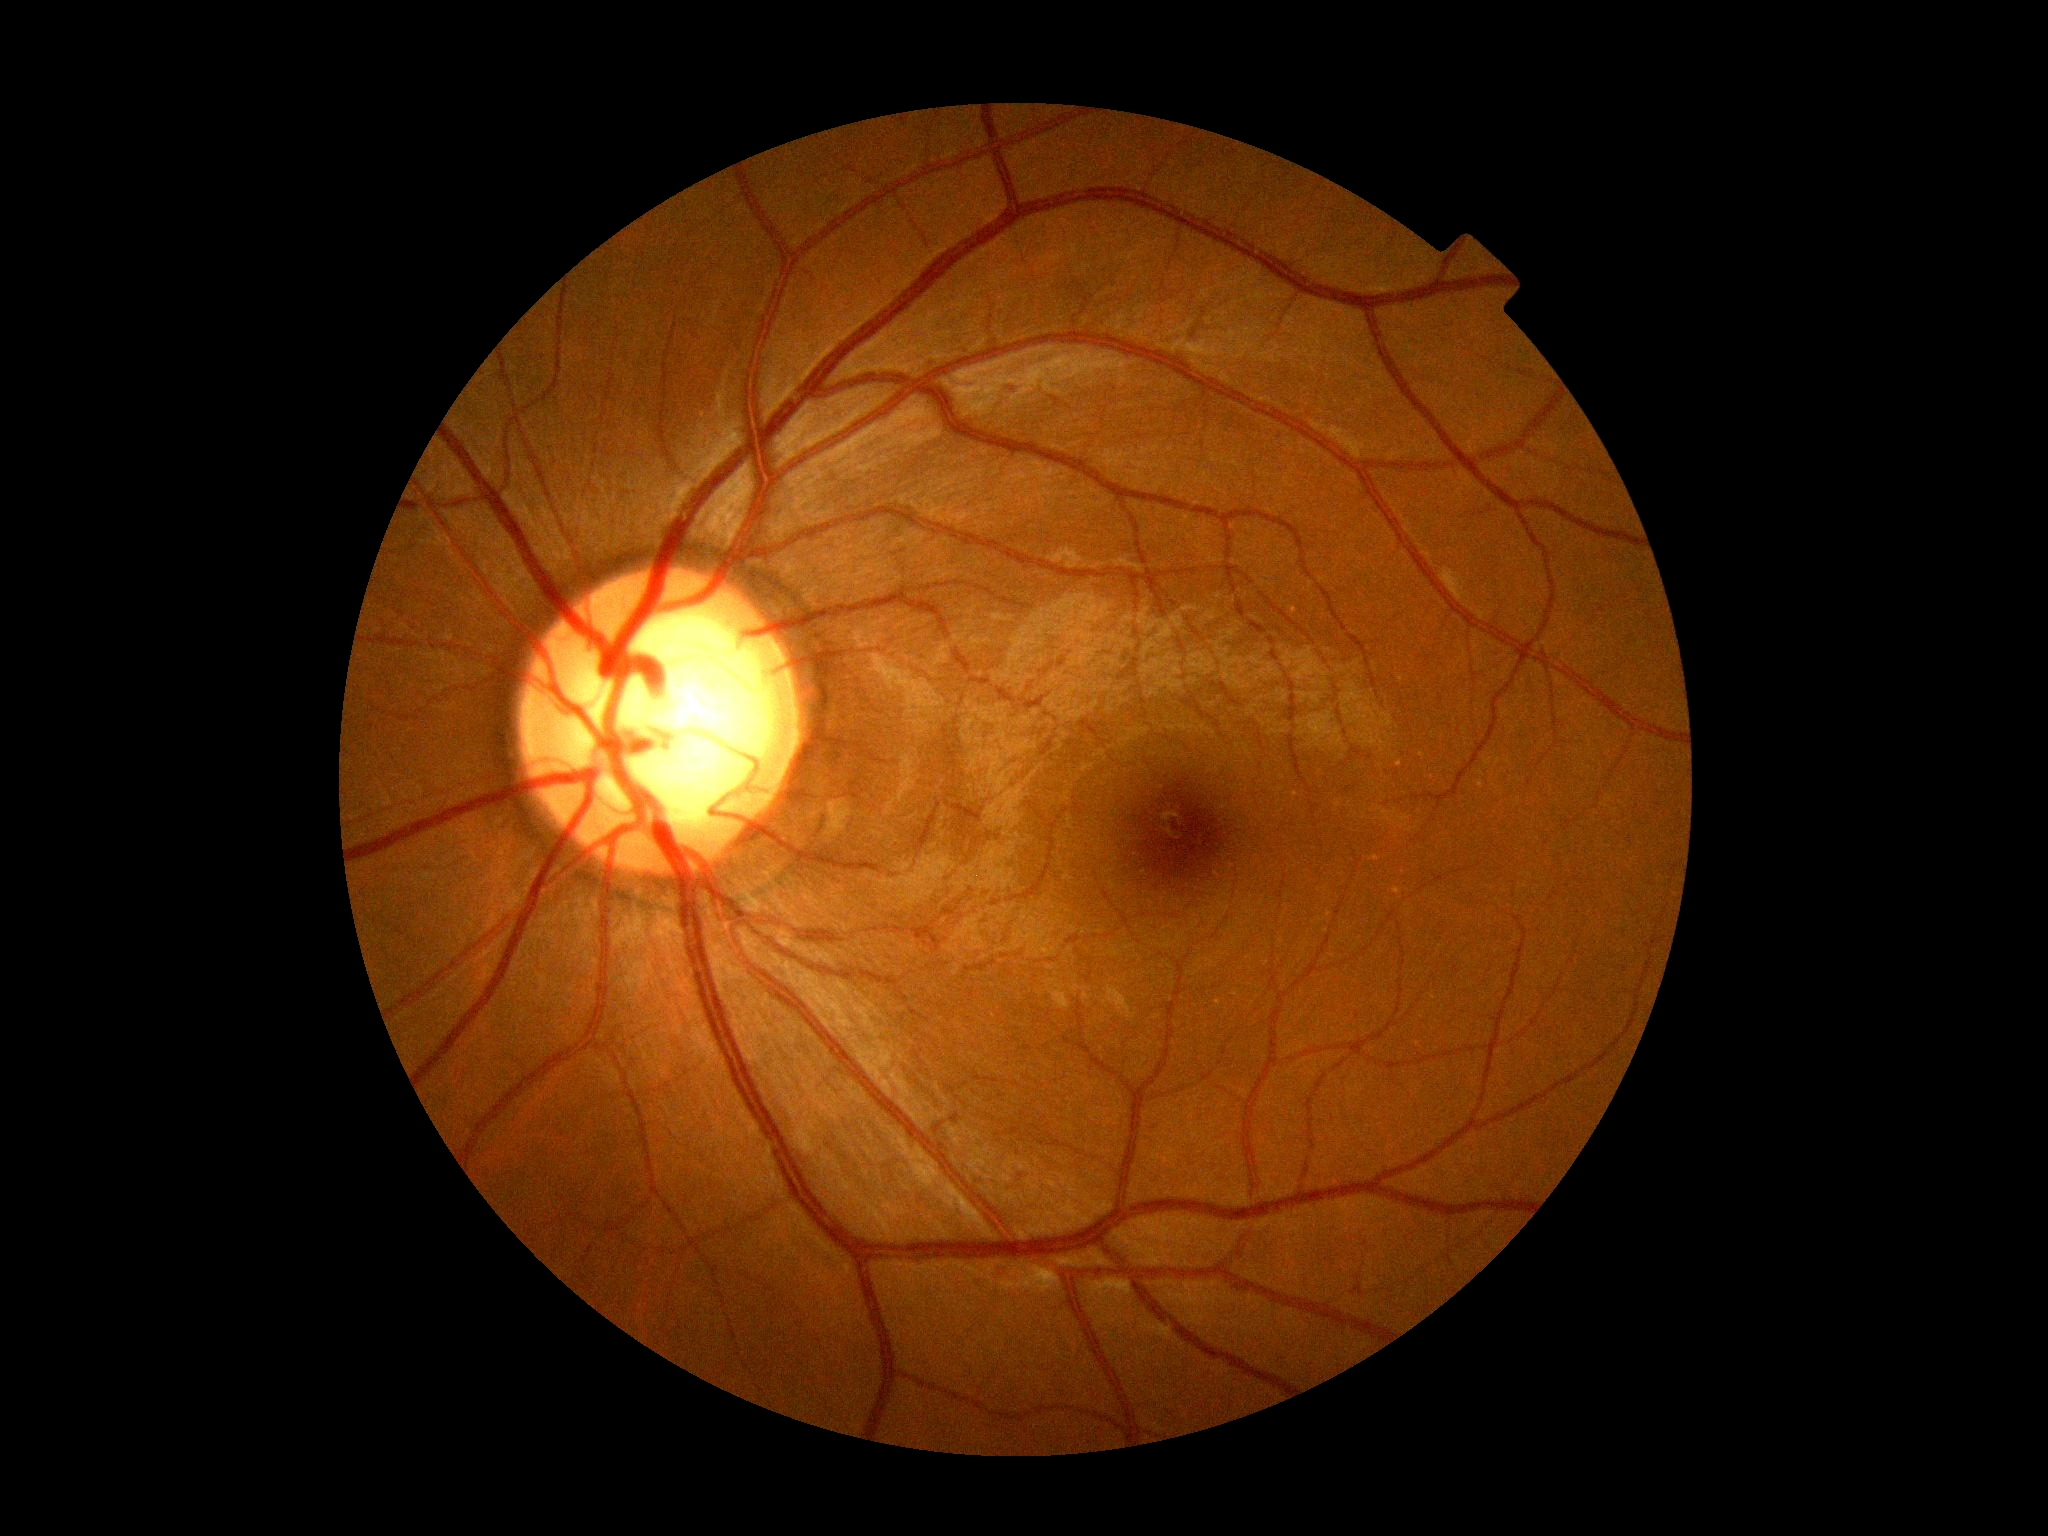

Diabetic retinopathy (DR) is grade 0 (no apparent retinopathy) — no visible signs of diabetic retinopathy.